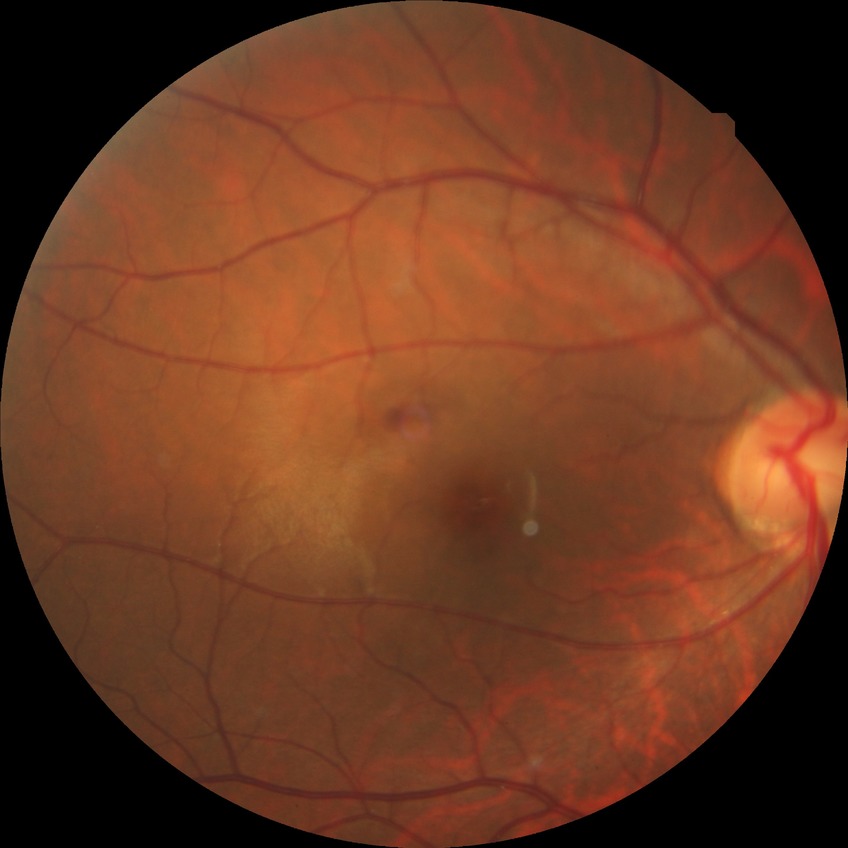

DR severity: NDR.
No apparent diabetic retinopathy.